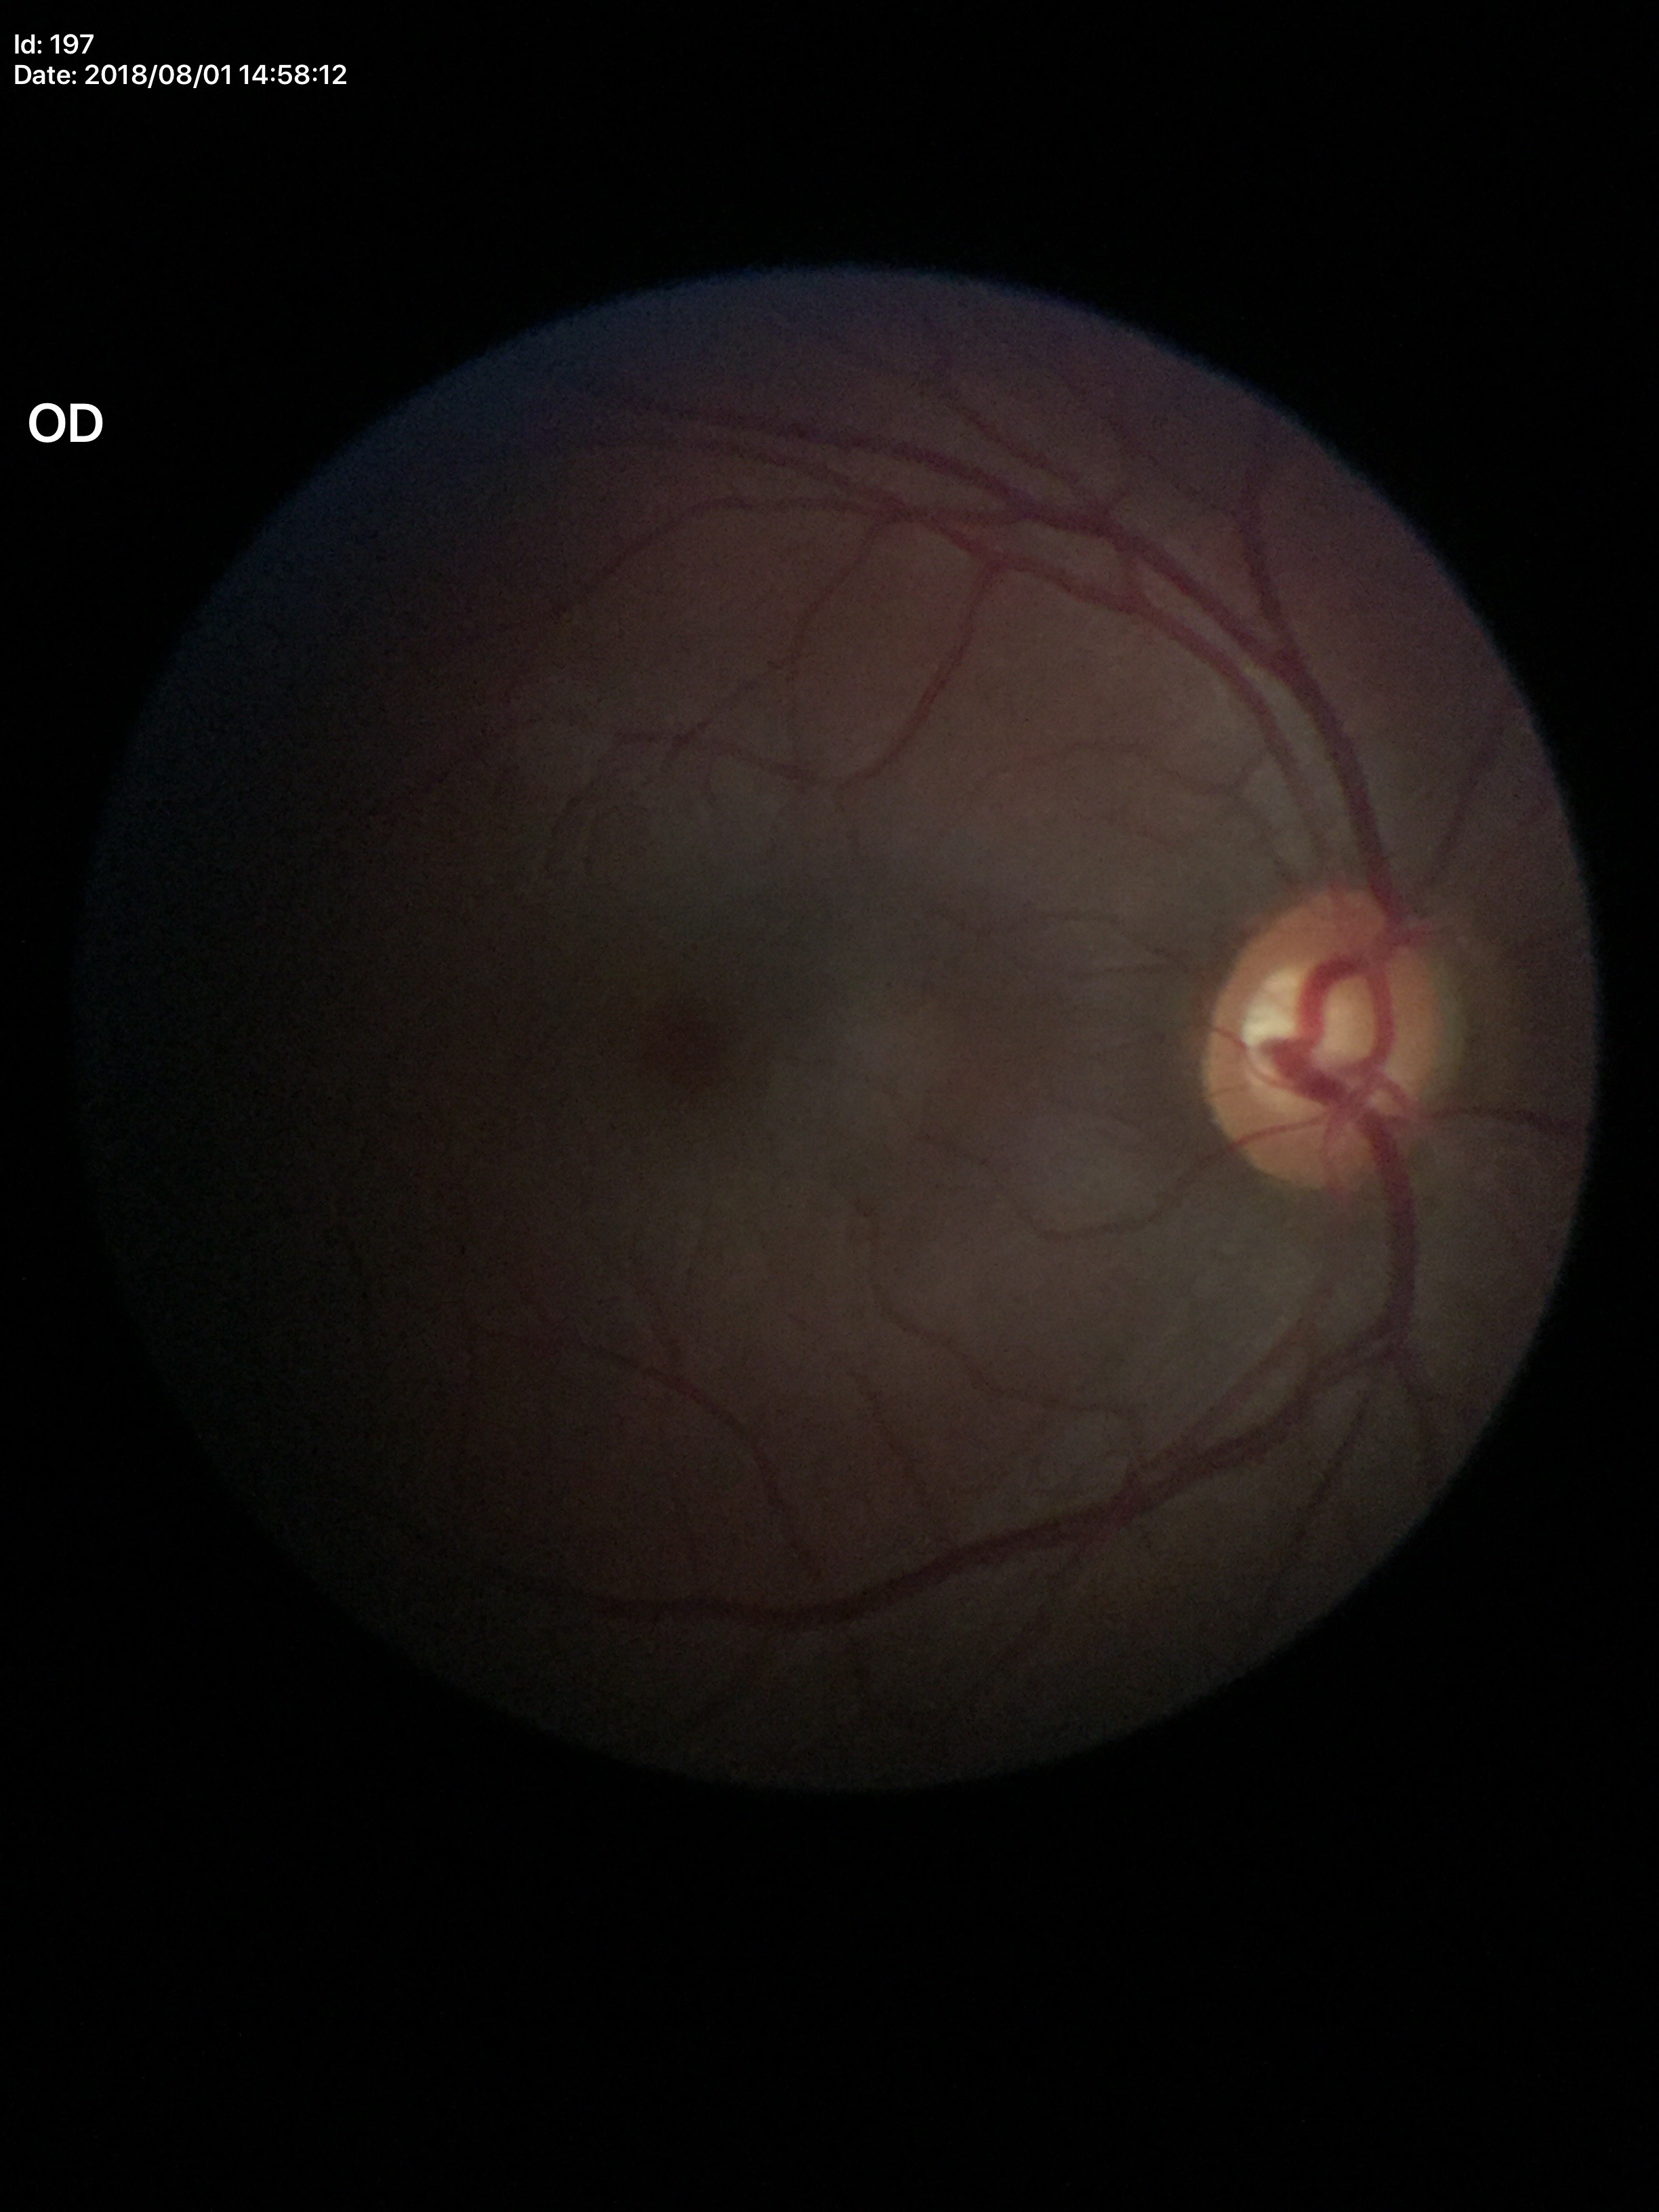

VCDR: 0.58 | Glaucoma evaluation: no suspicious findings (1 of 5 graders flagged glaucoma suspect)